Wide-field fundus photograph of an infant: 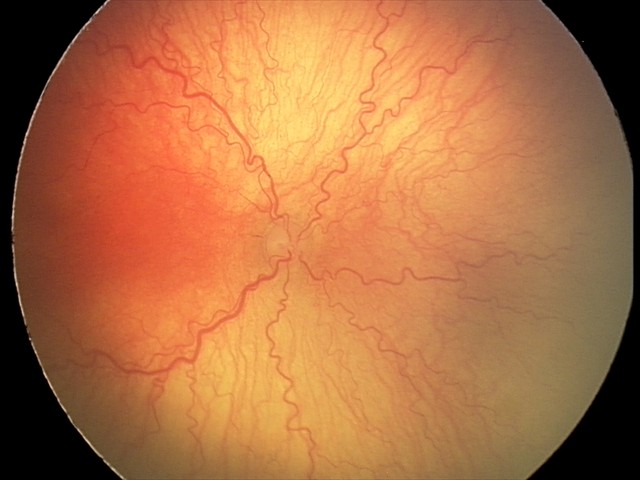
Series diagnosed as aggressive retinopathy of prematurity. Plus disease present.